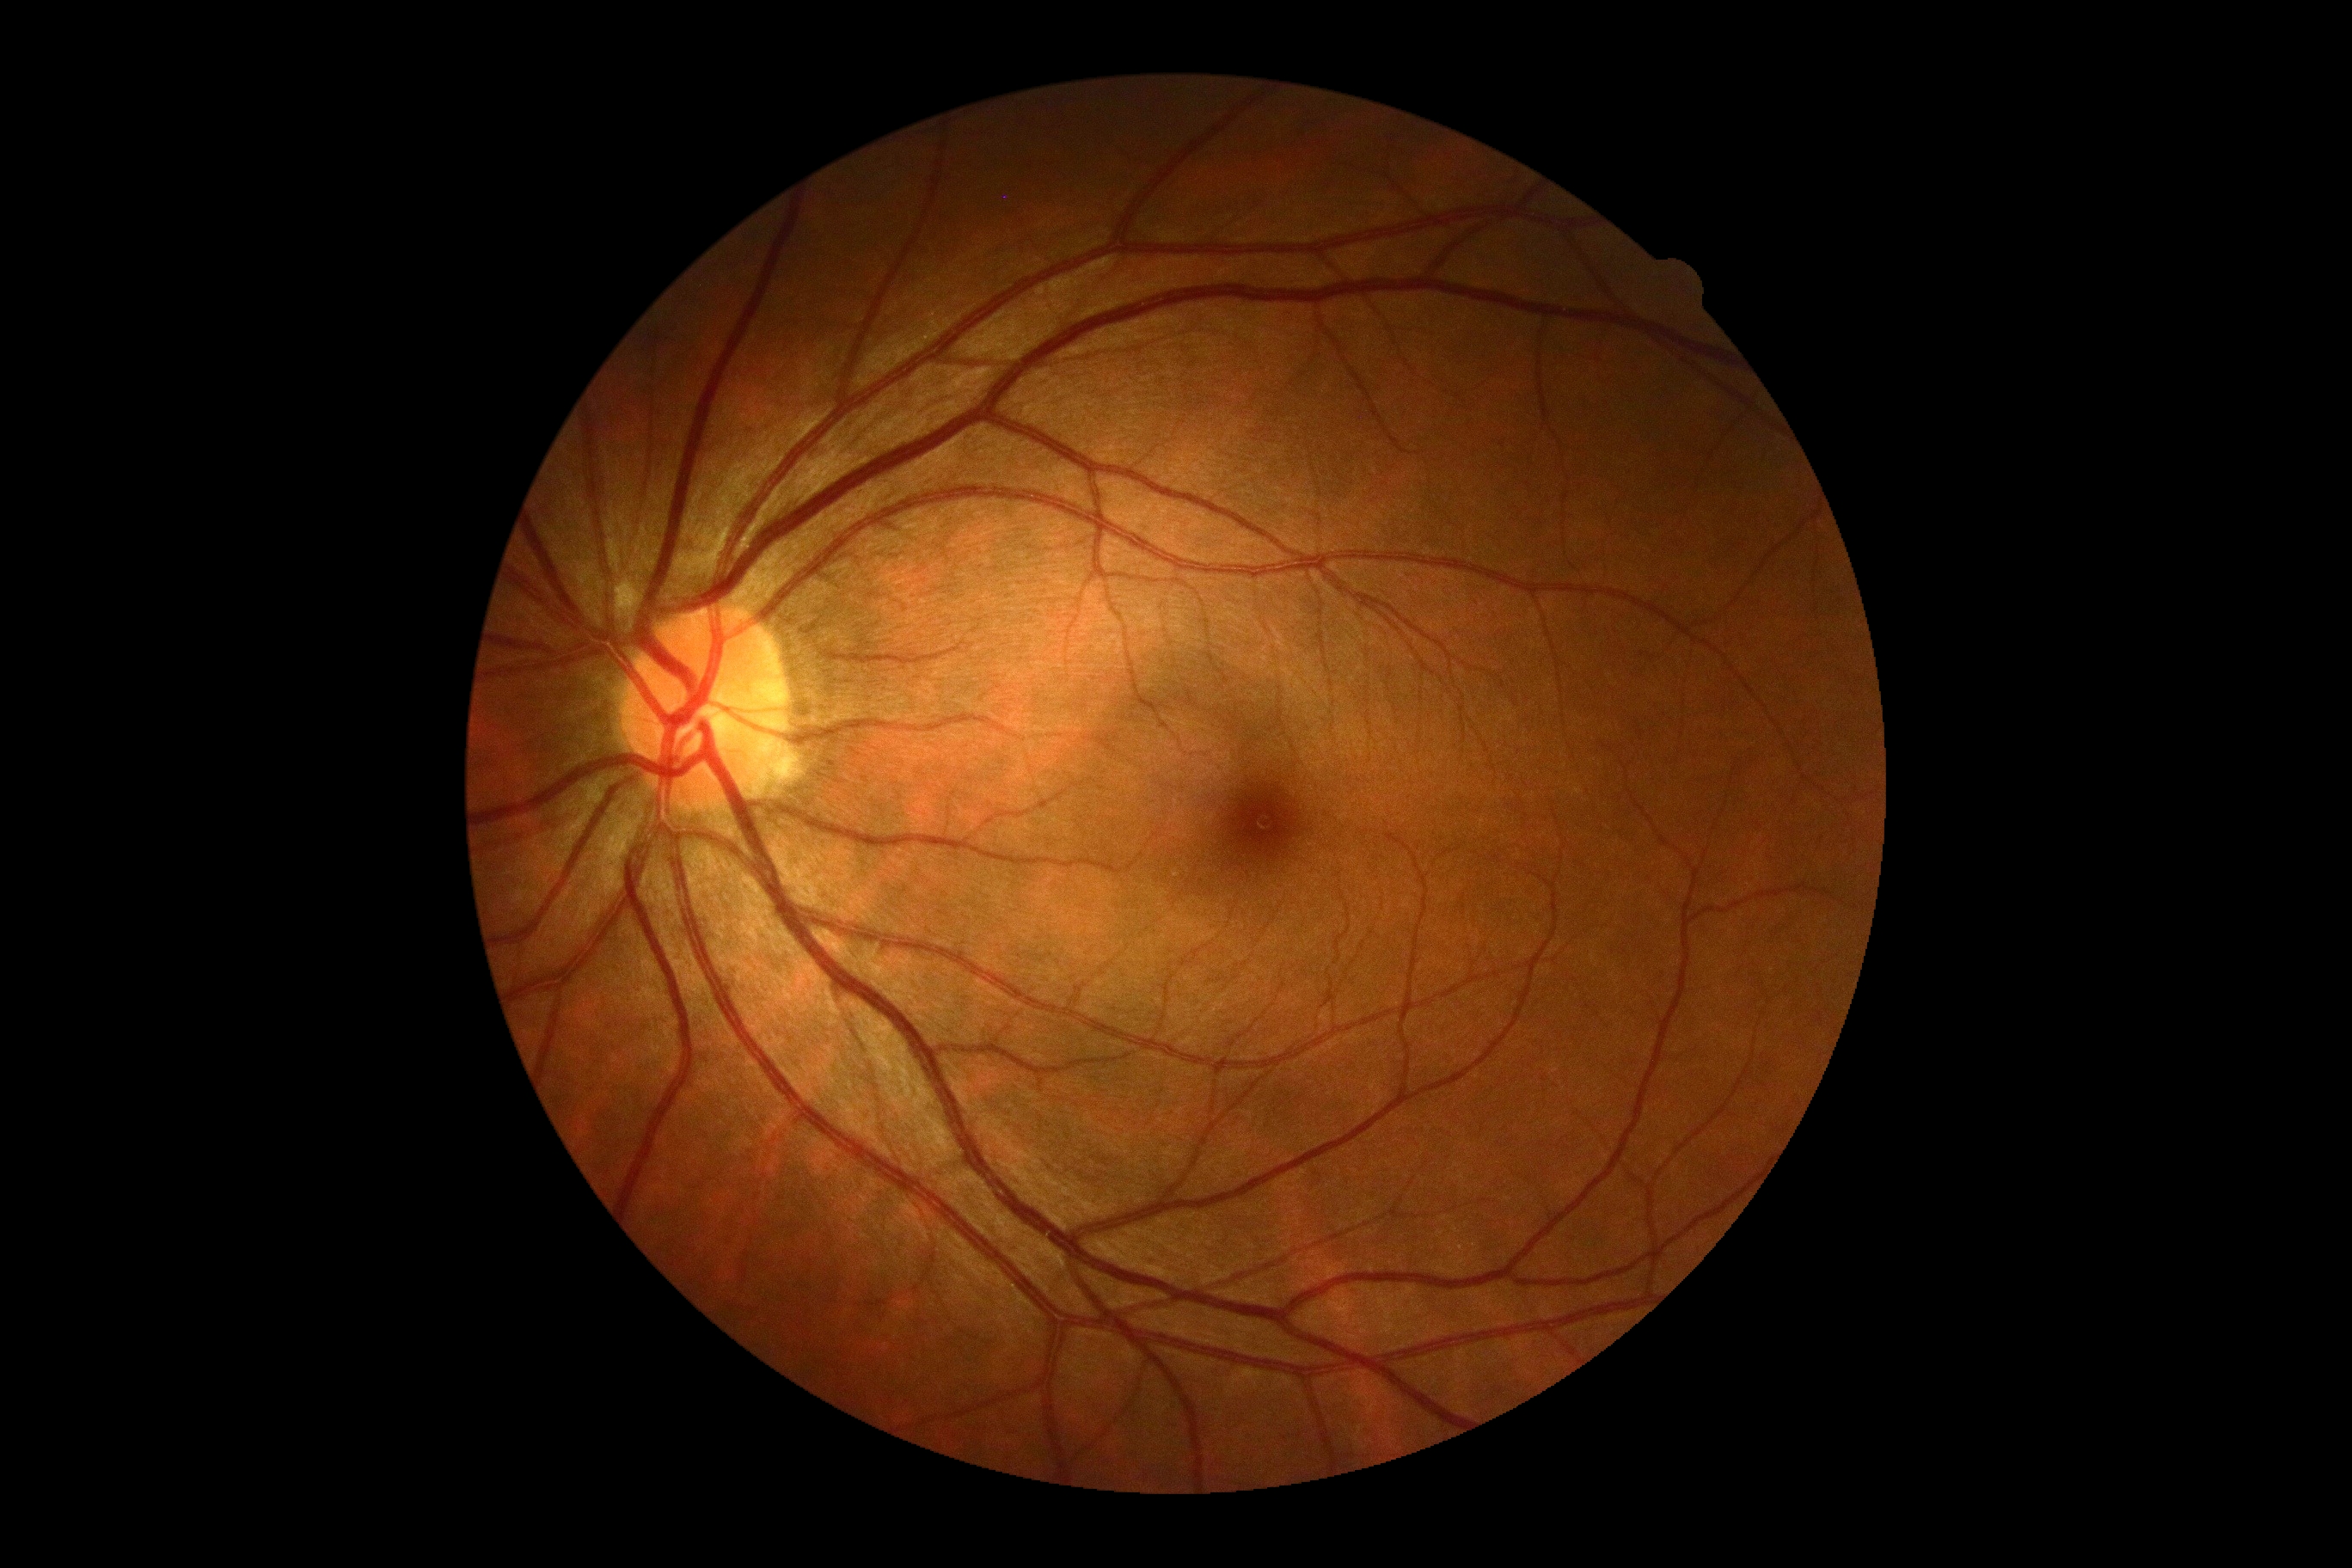 DR: 0 — no visible signs of diabetic retinopathy. No diabetic retinal disease findings.